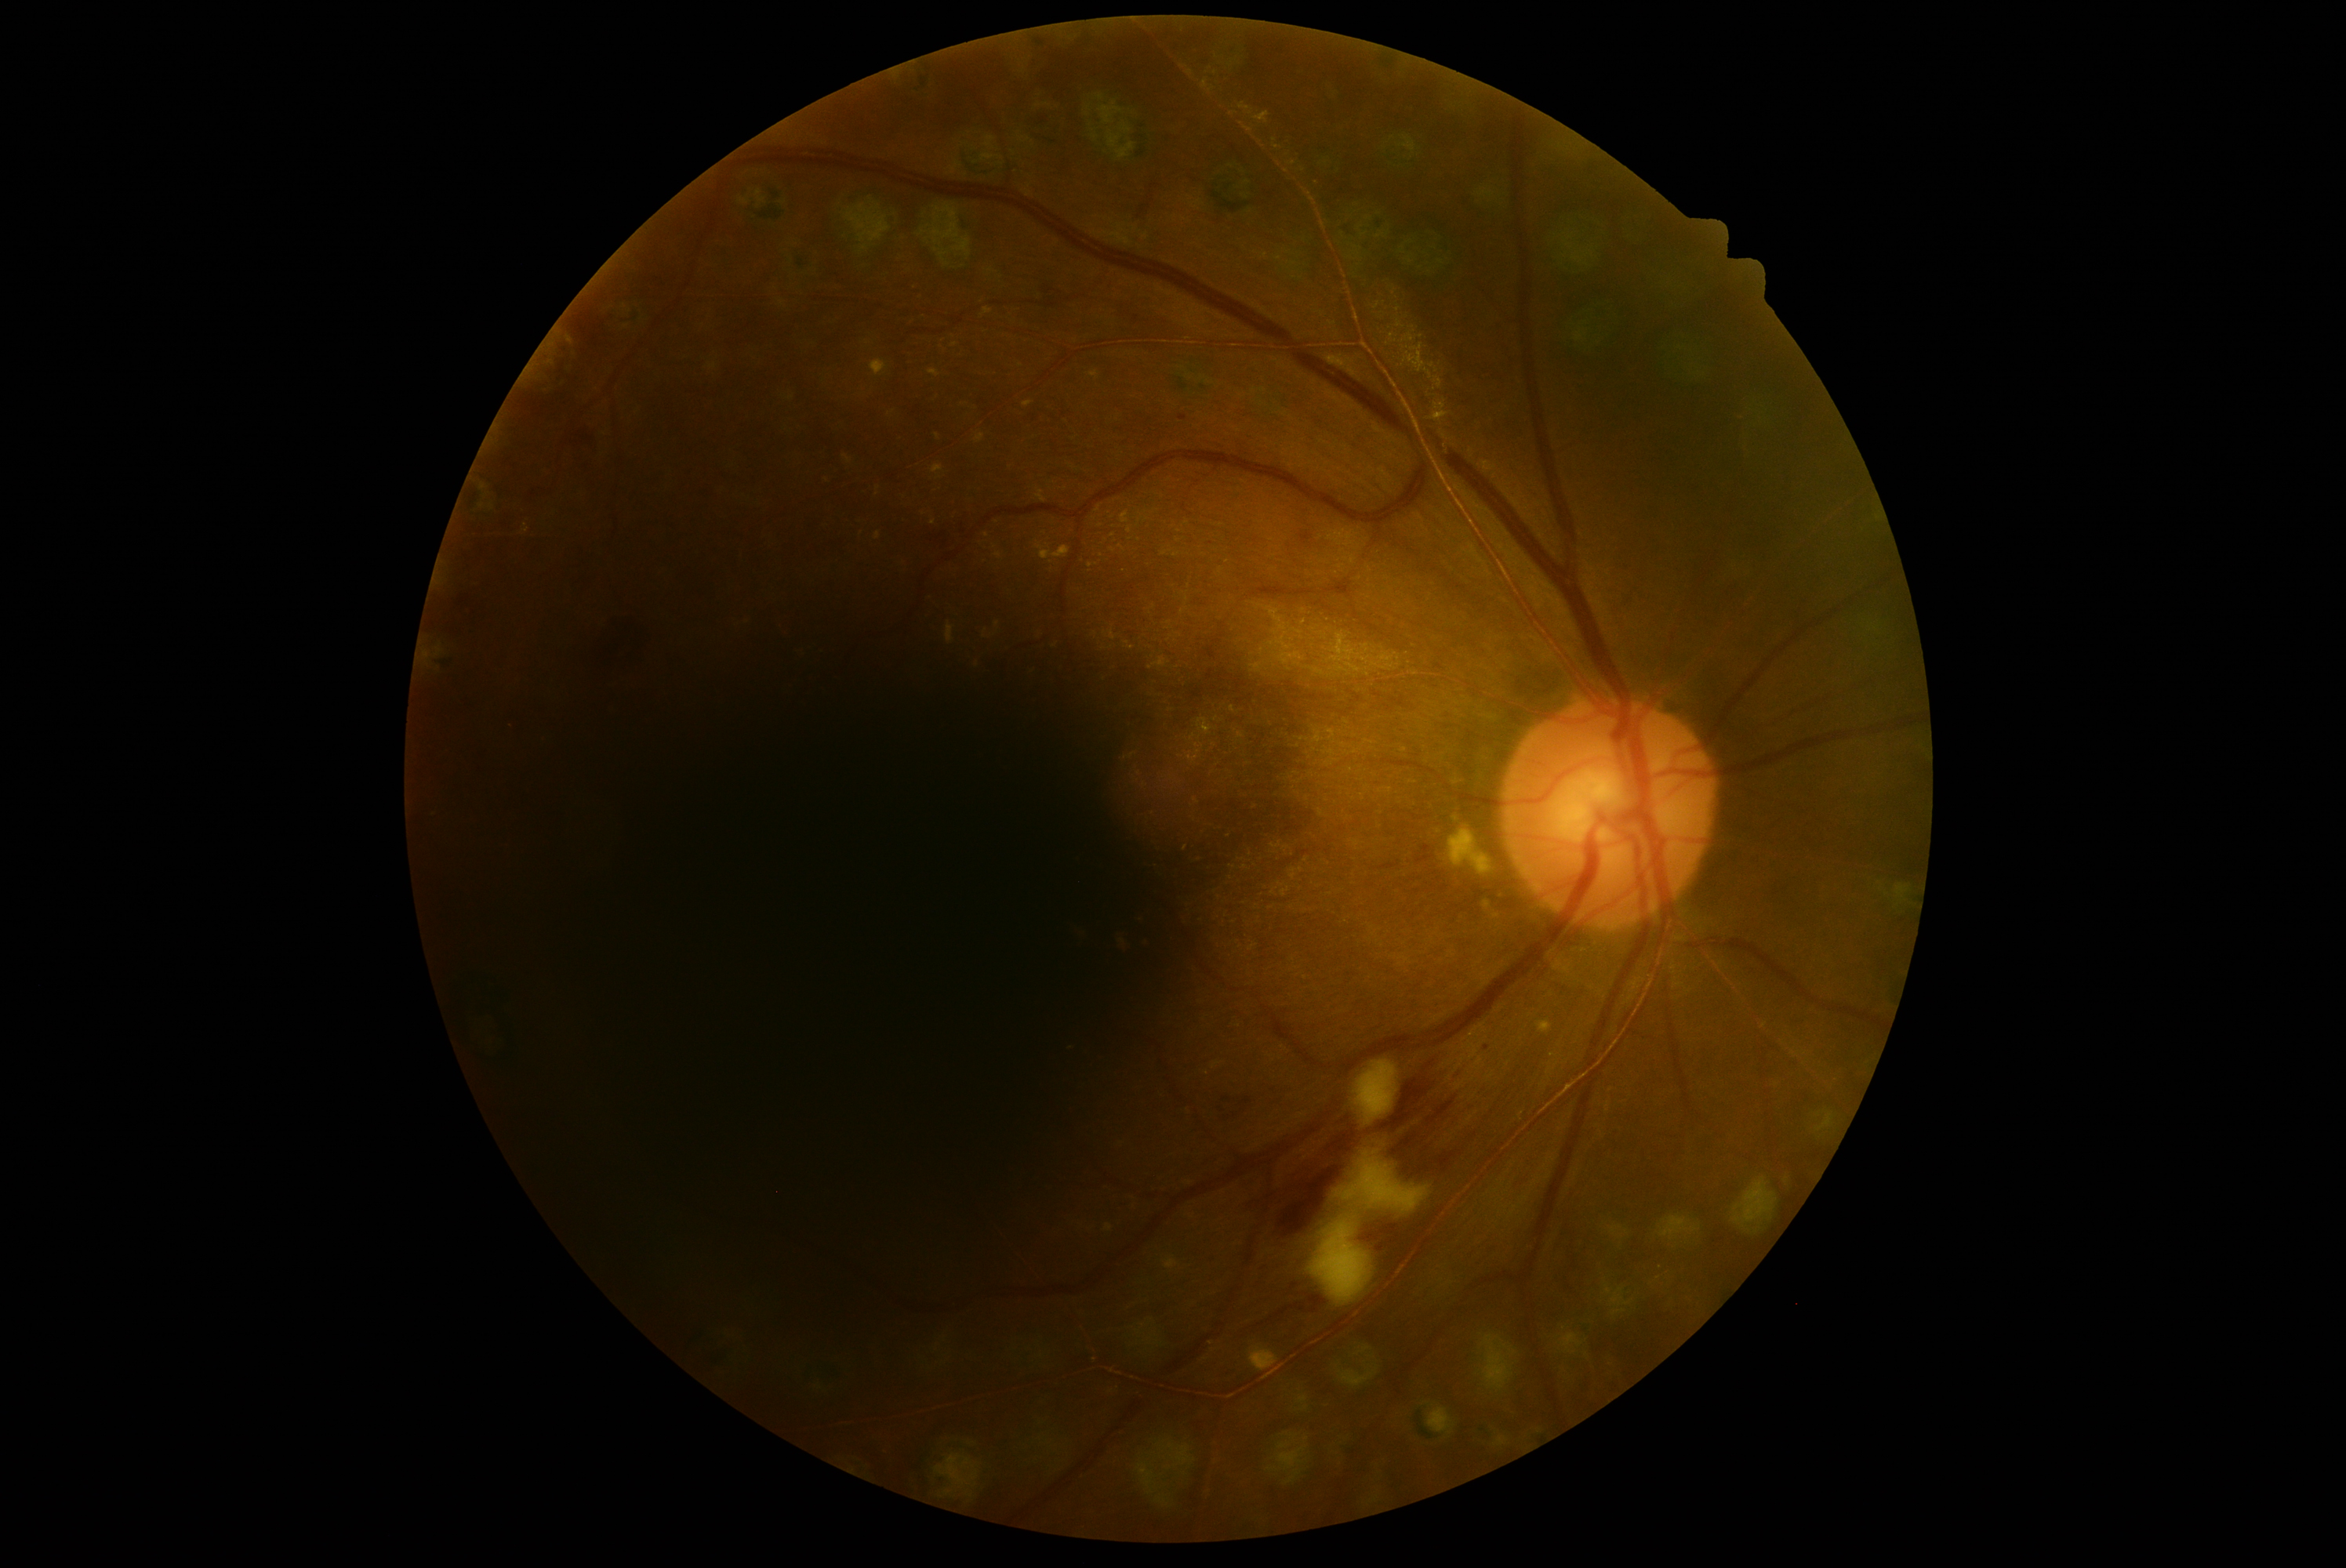

  dr_grade: grade 2